2048x1536px: 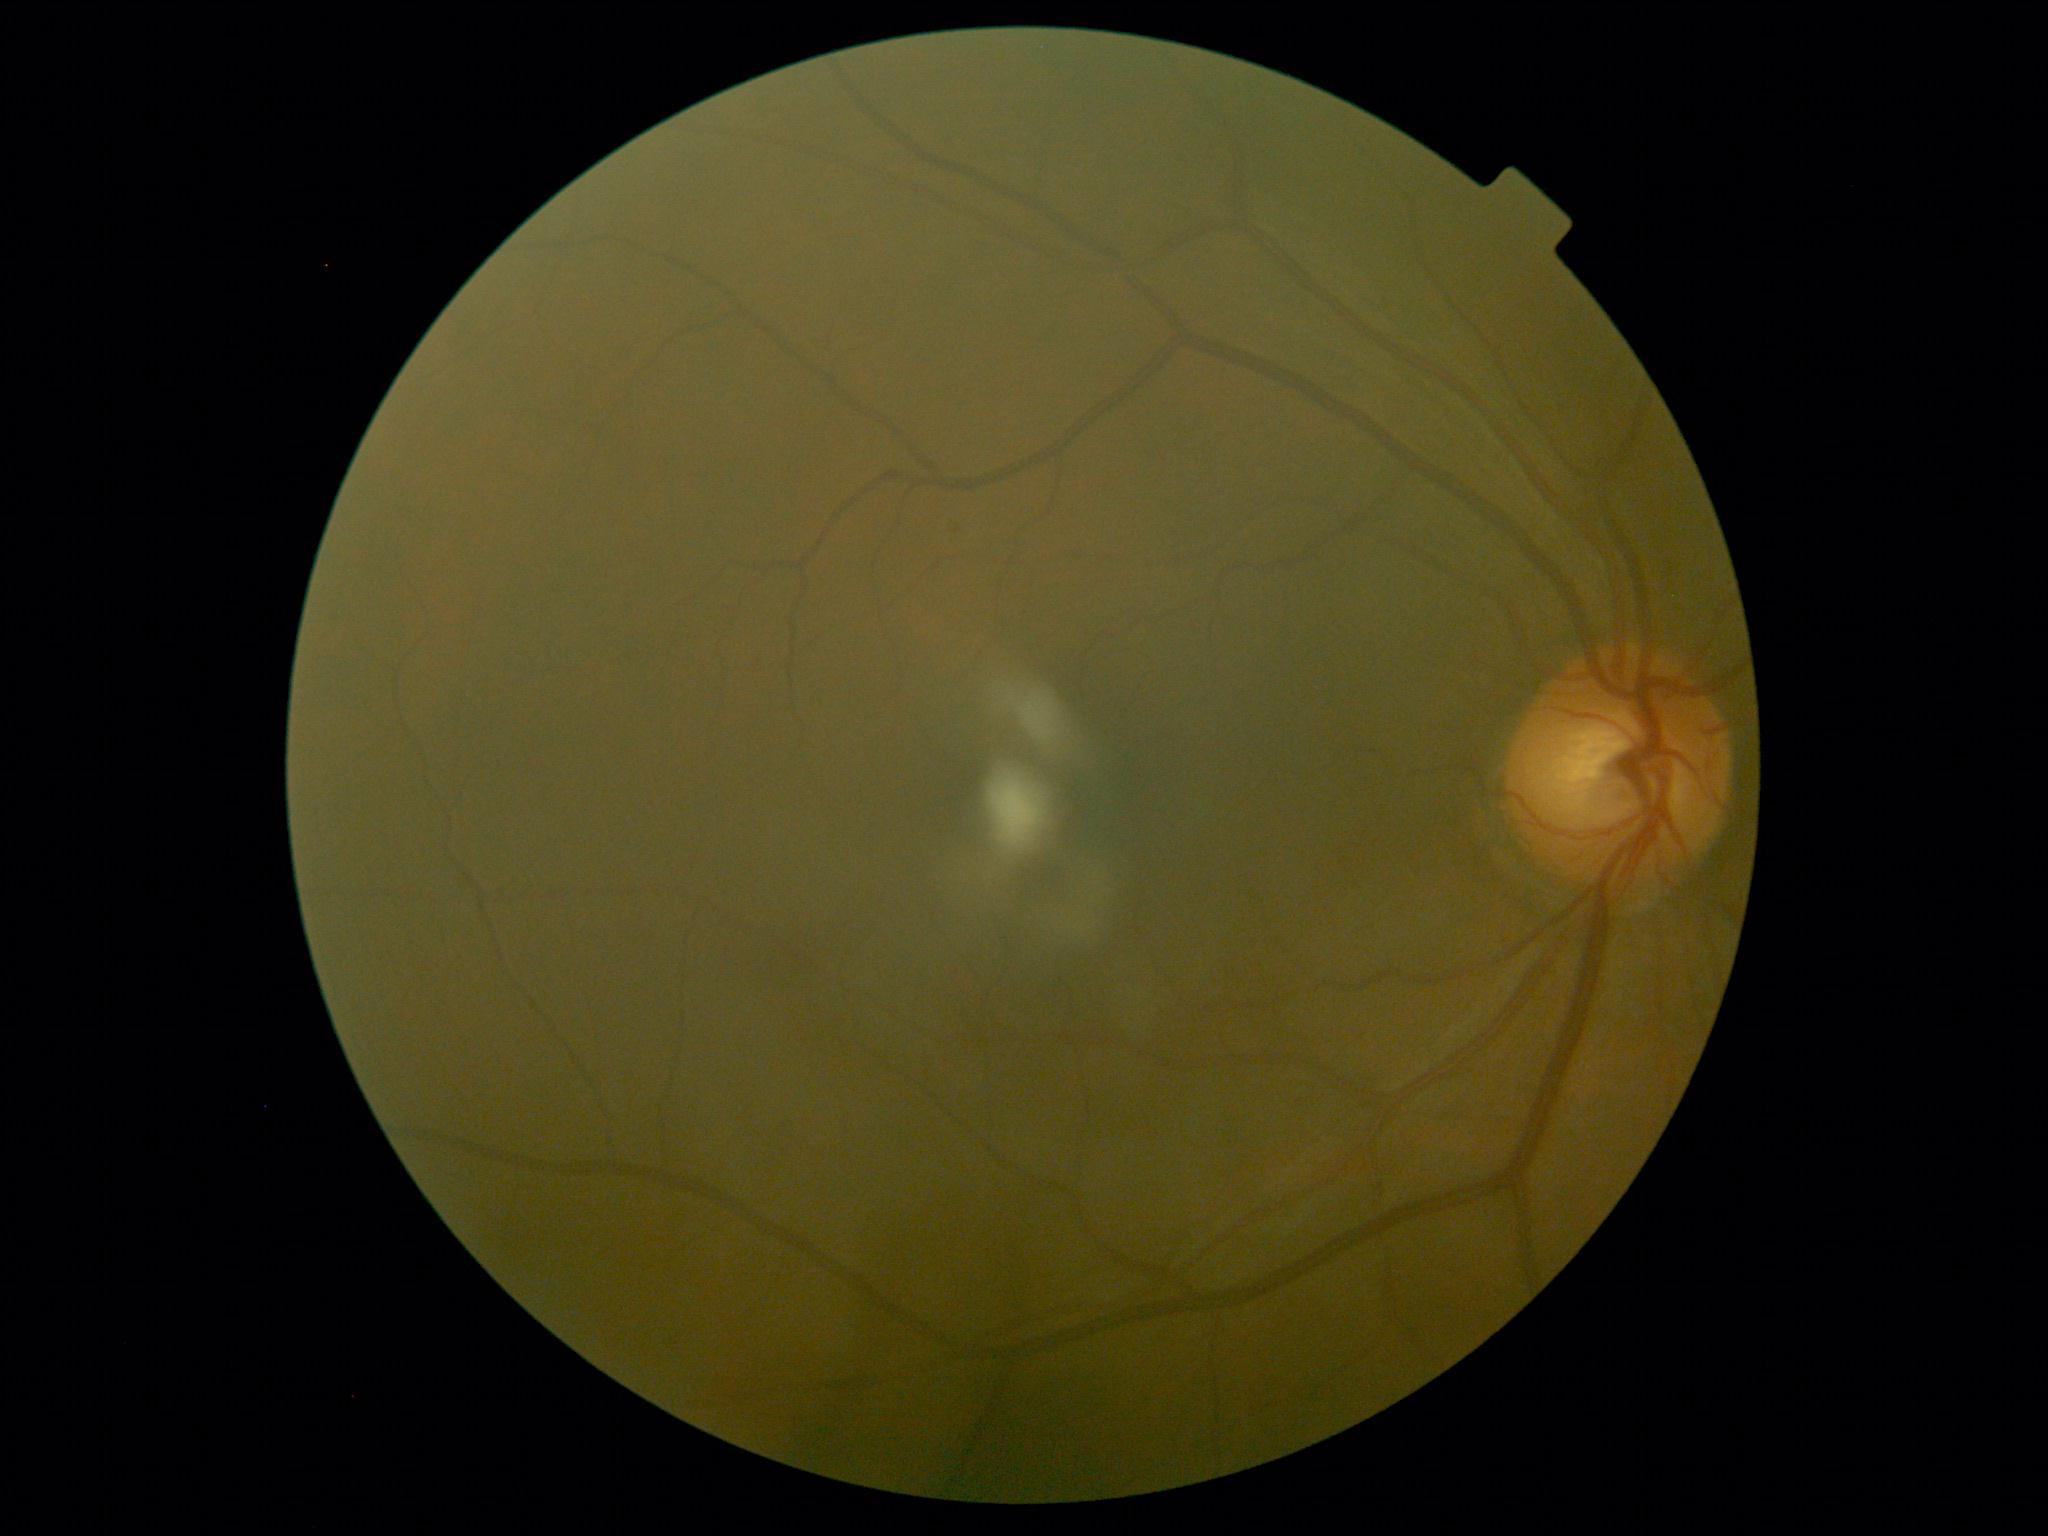

Findings:
- diabetic retinopathy (DR) — mild non-proliferative diabetic retinopathy (grade 1)